Color fundus photograph; 2352 by 1568 pixels — 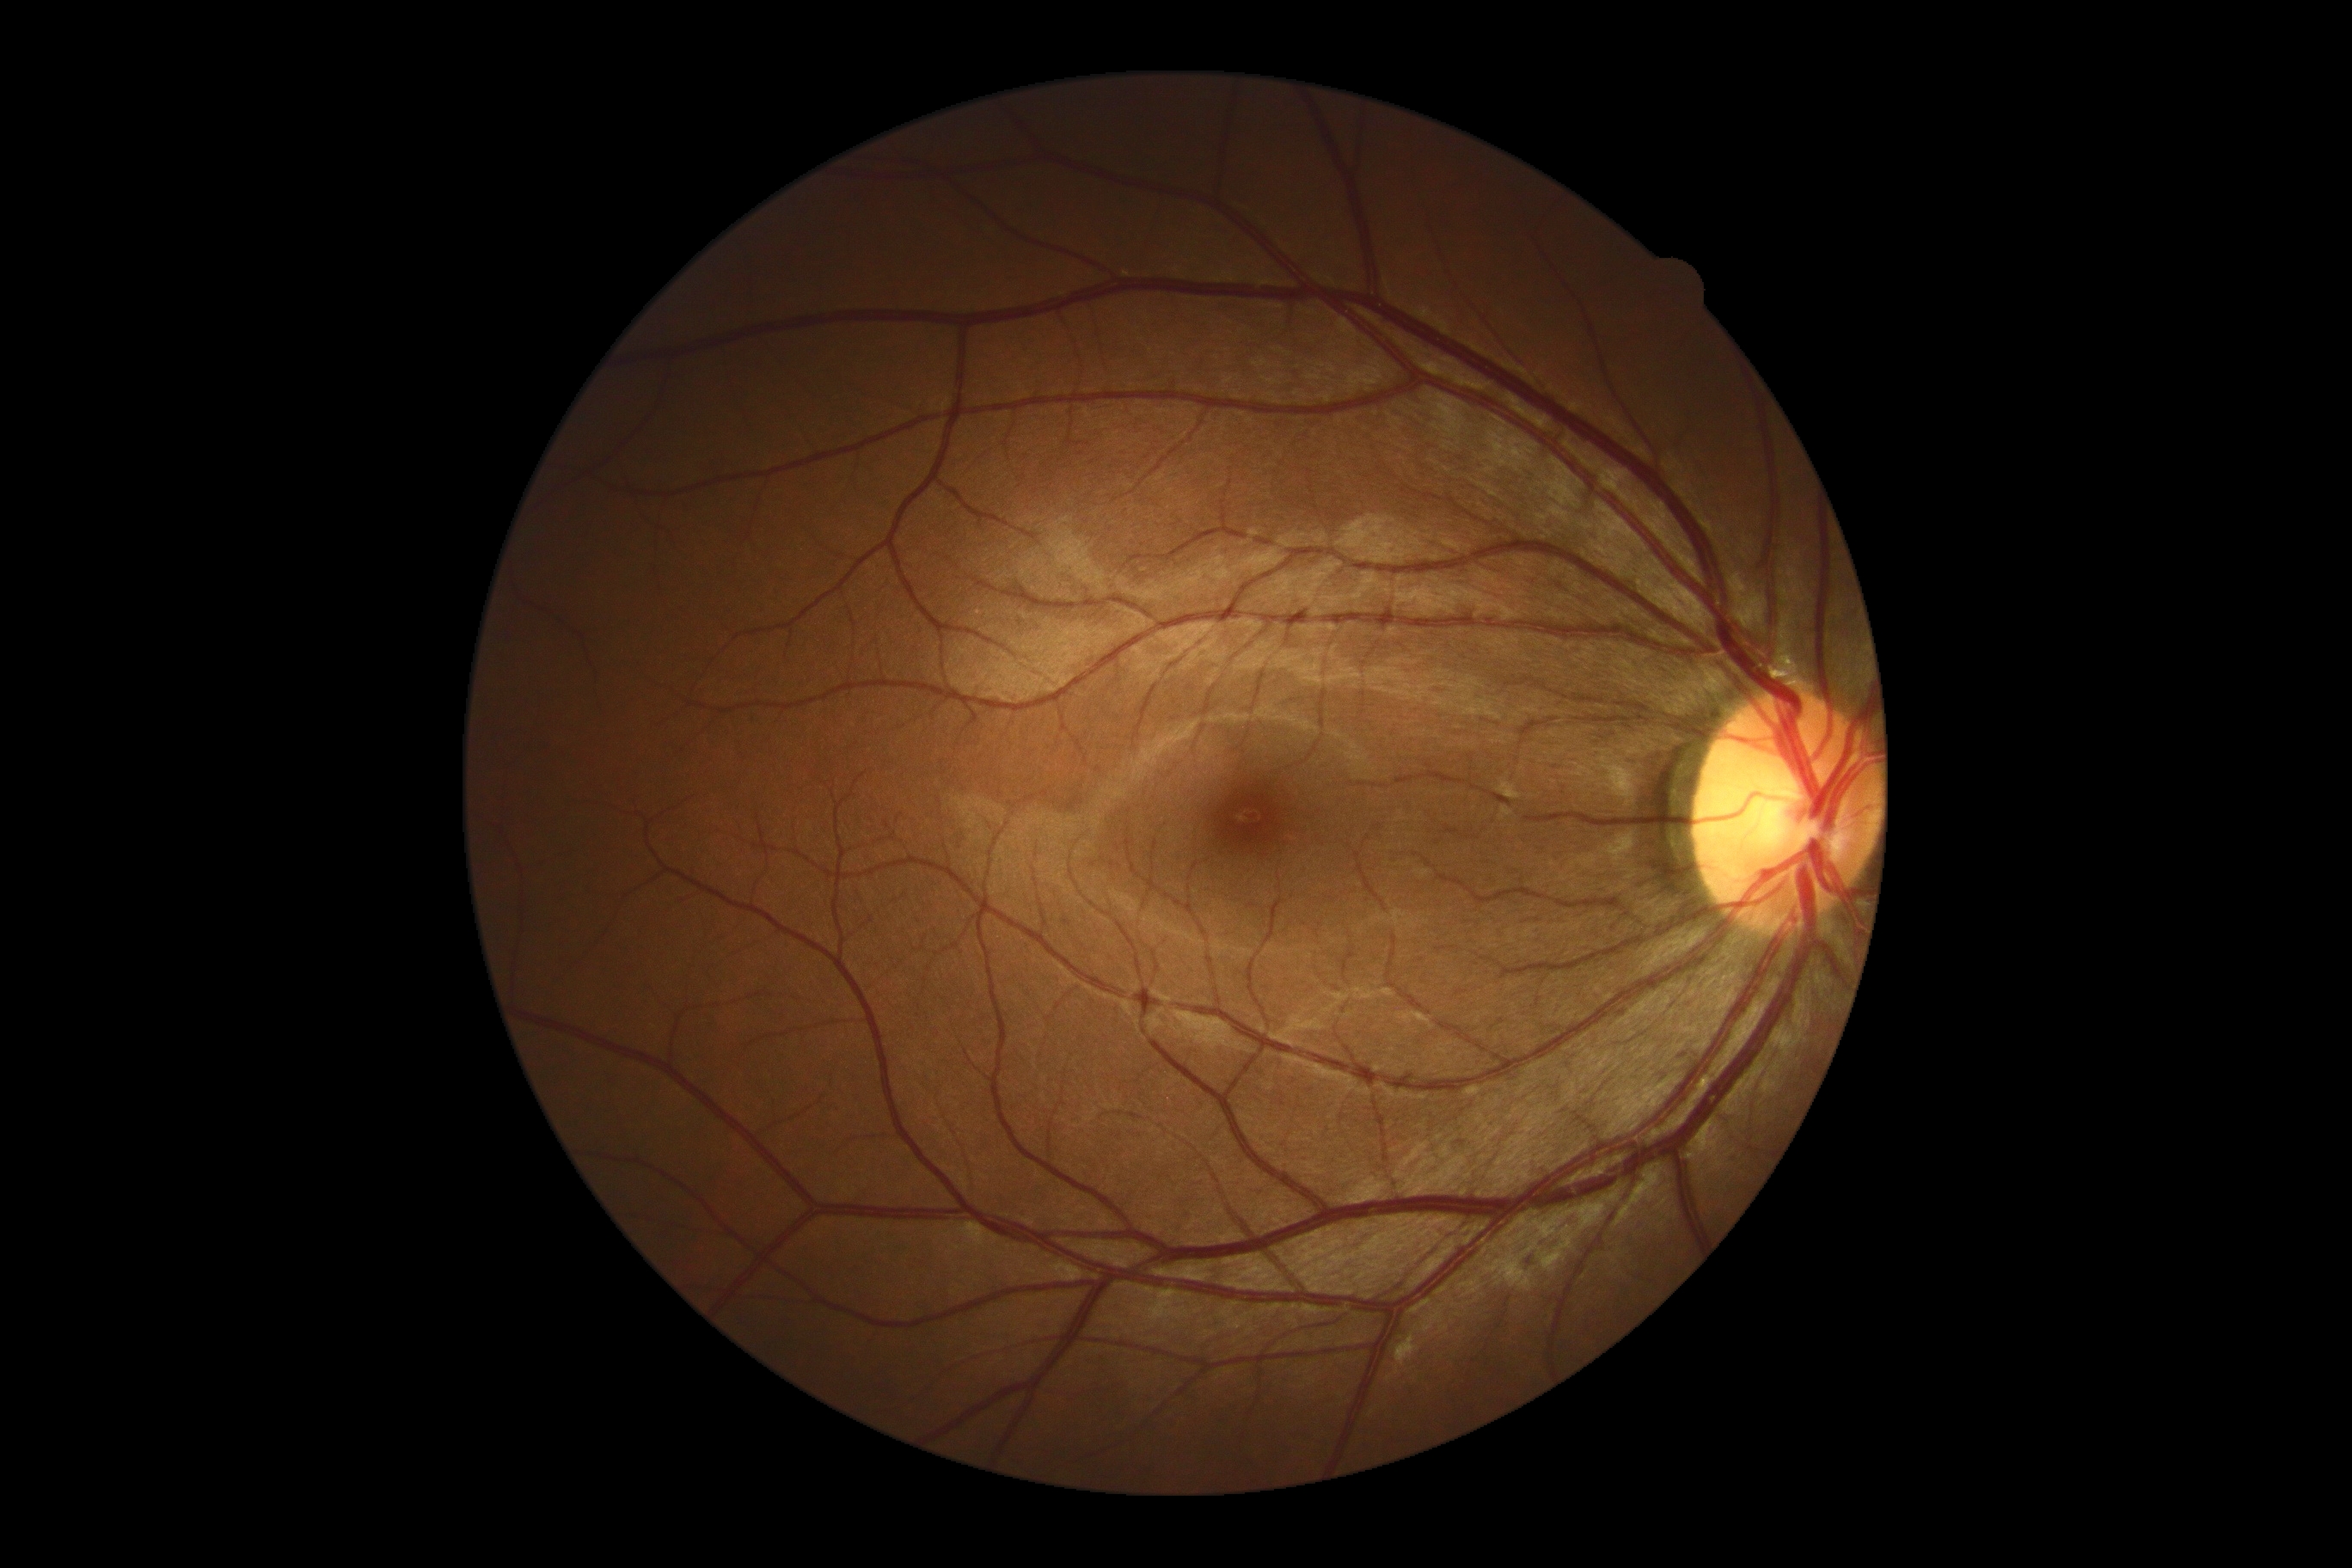
DR impression: no signs of DR, diabetic retinopathy (DR): grade 0 (no apparent retinopathy).